FOV: 45 degrees · color fundus photograph · 2352x1568: 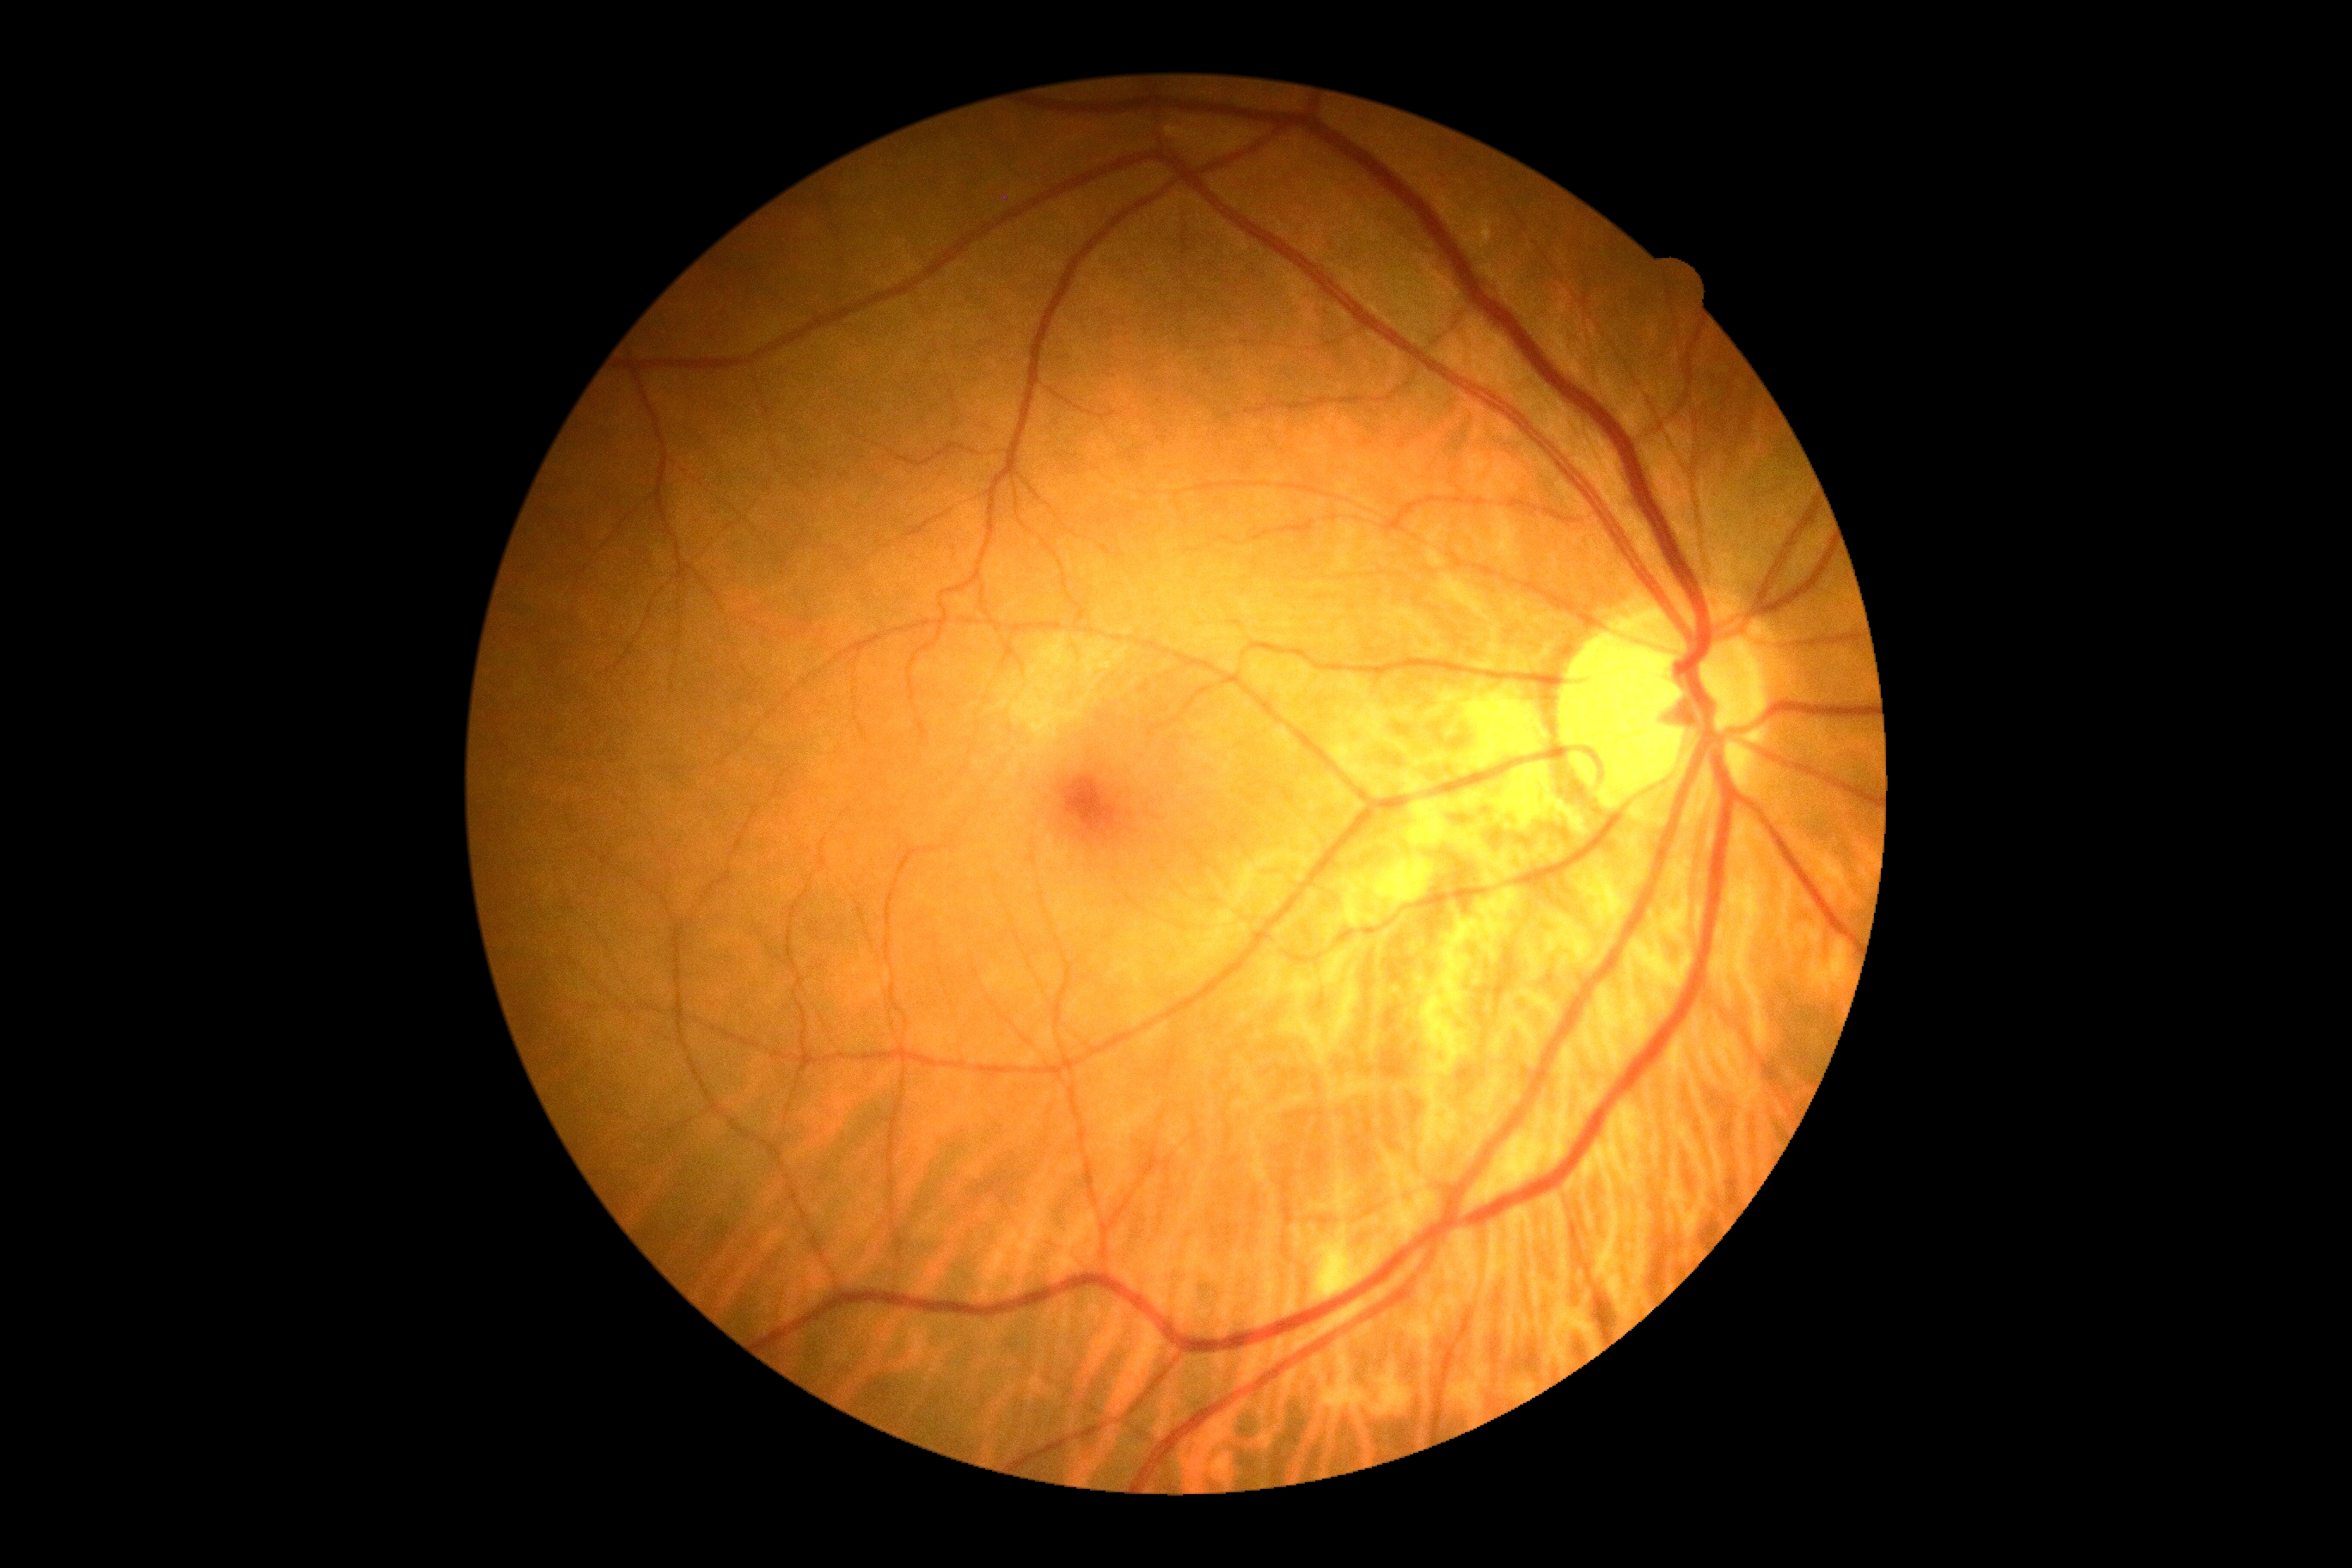 Diabetic retinopathy (DR): 0. No apparent diabetic retinopathy.